2048 by 1536 pixels. FOV: 45 degrees. Retinal fundus photograph
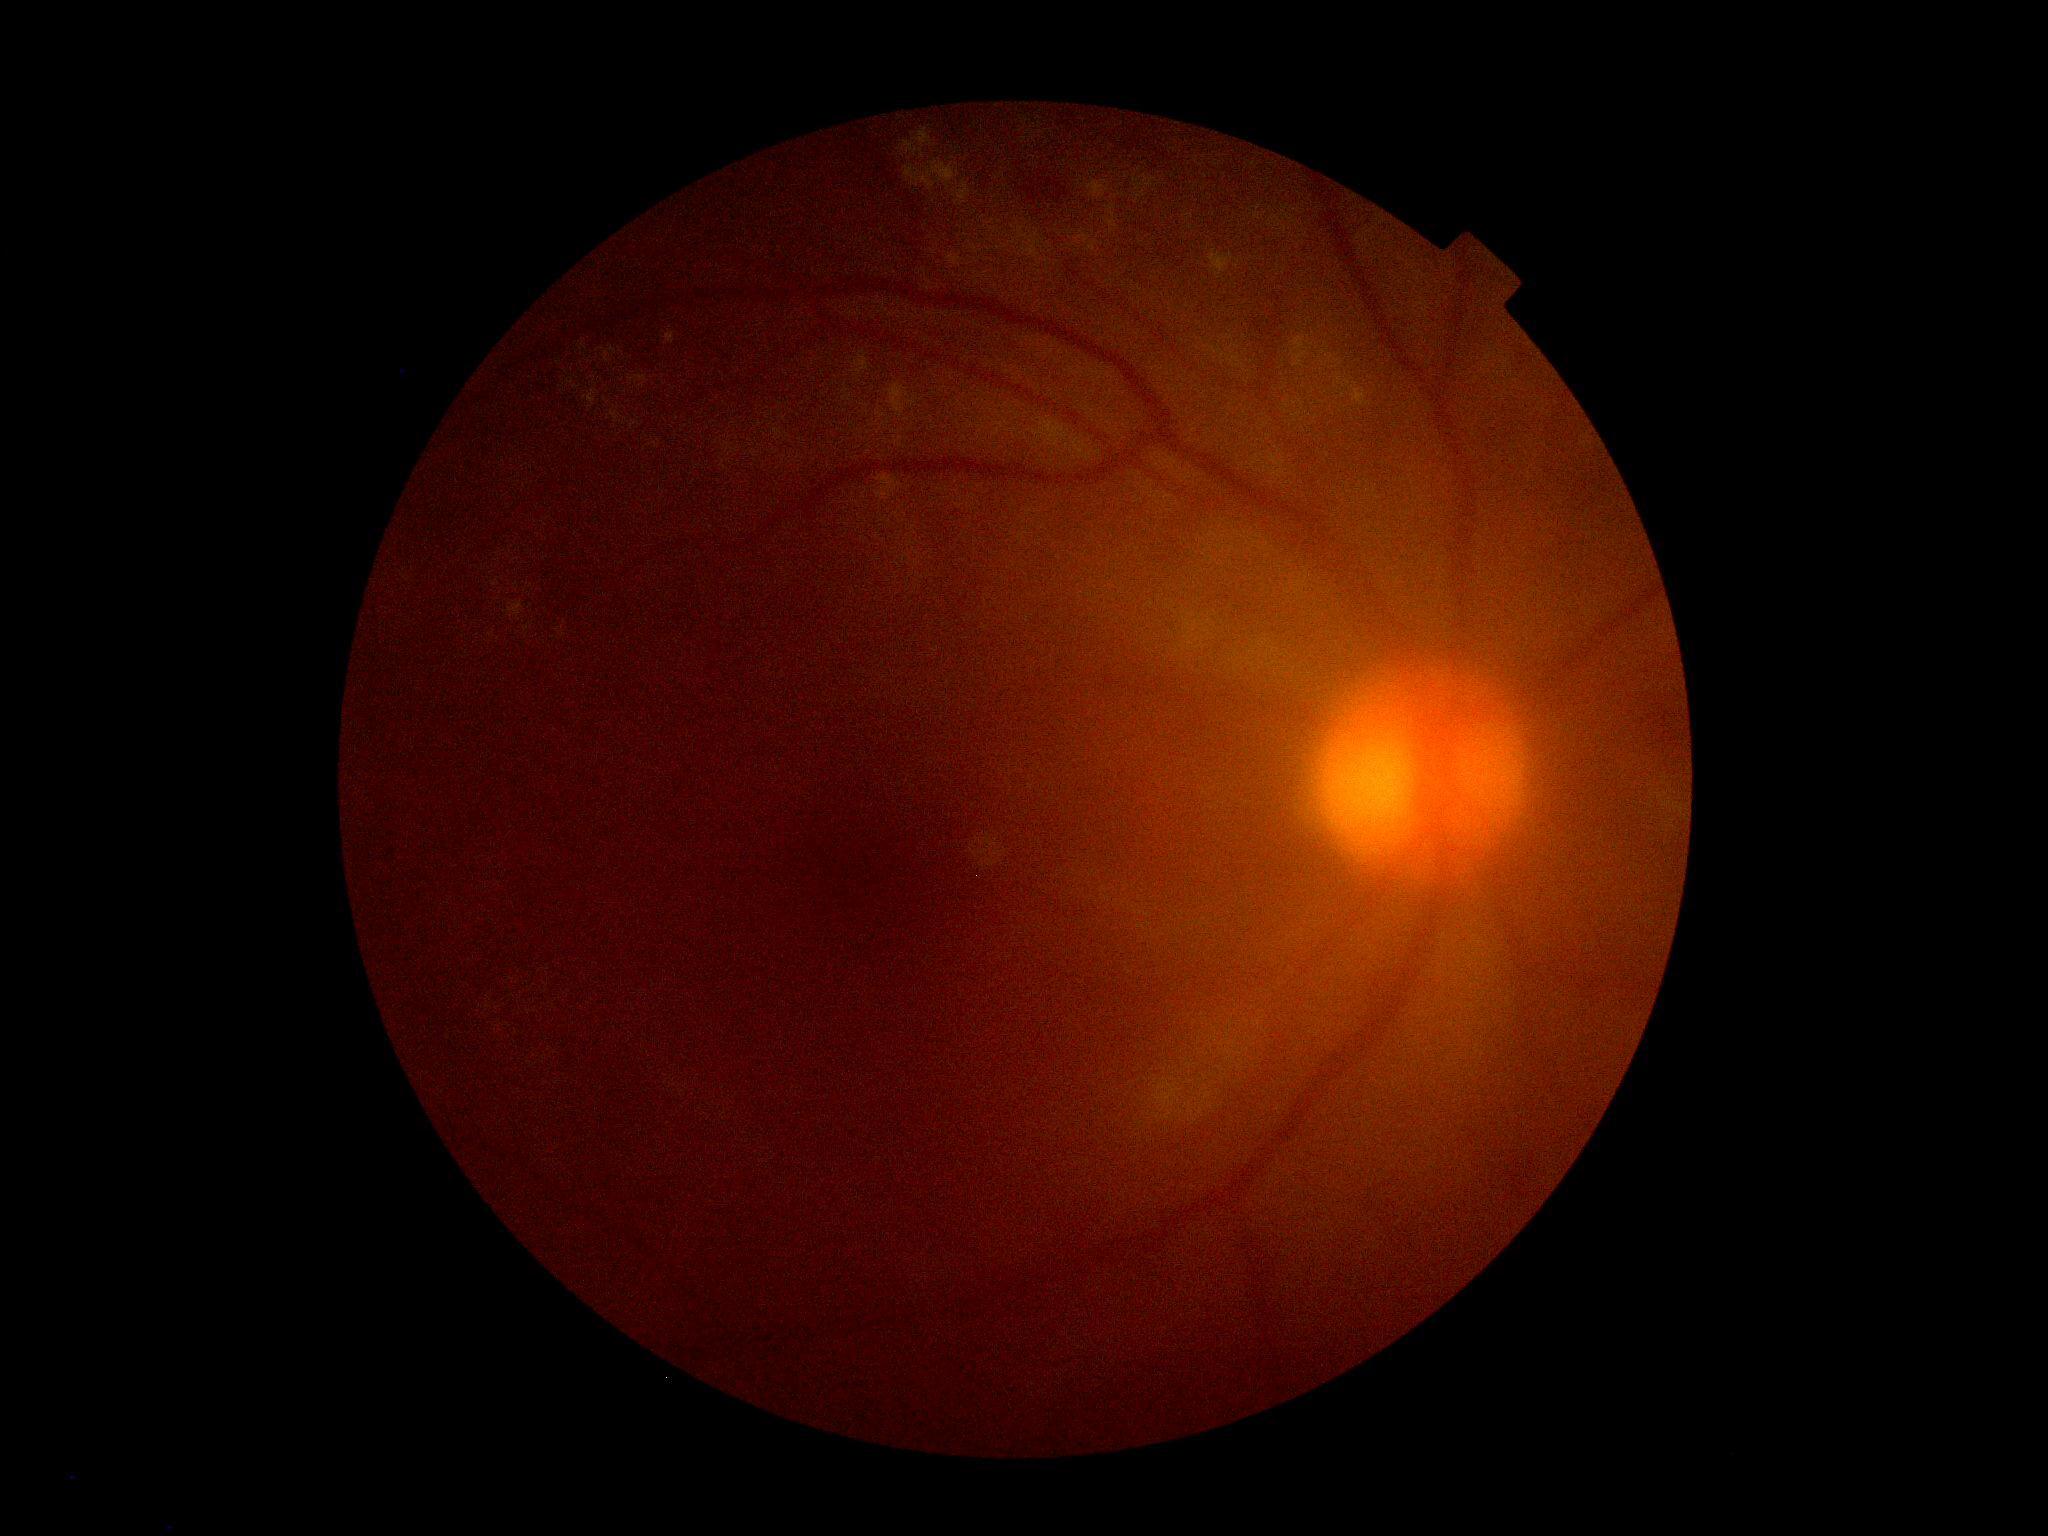

DR grade=2, DR class=non-proliferative diabetic retinopathy.